Image size 848x848
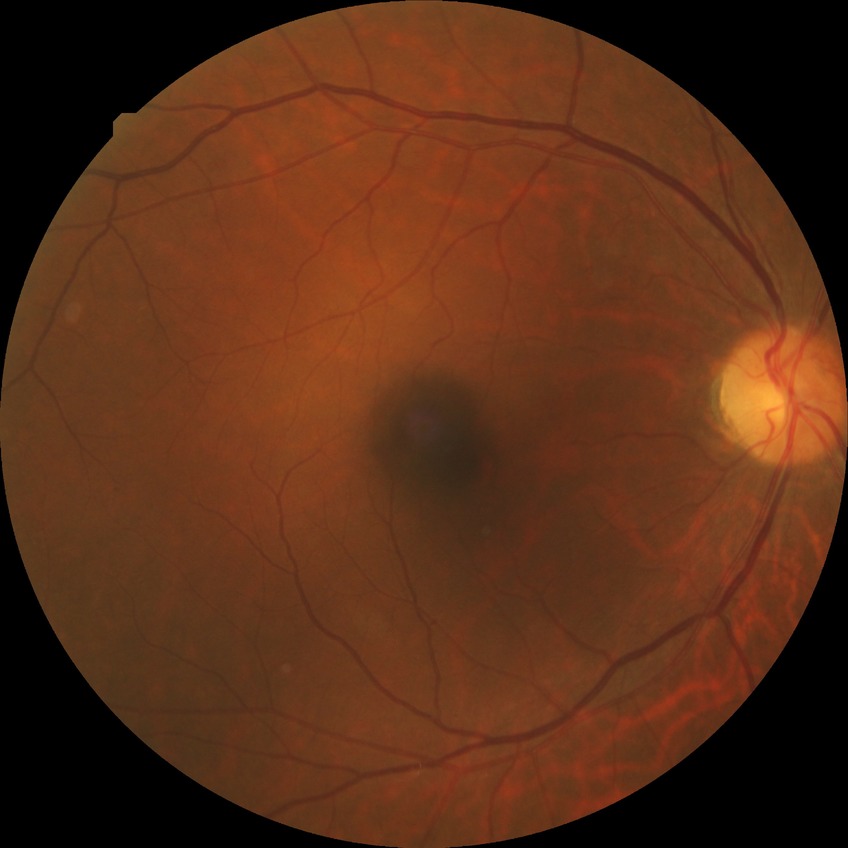 Retinopathy stage is no diabetic retinopathy.